Retinal fundus photograph, 848 x 848 pixels, DR severity per modified Davis staging, FOV: 45 degrees
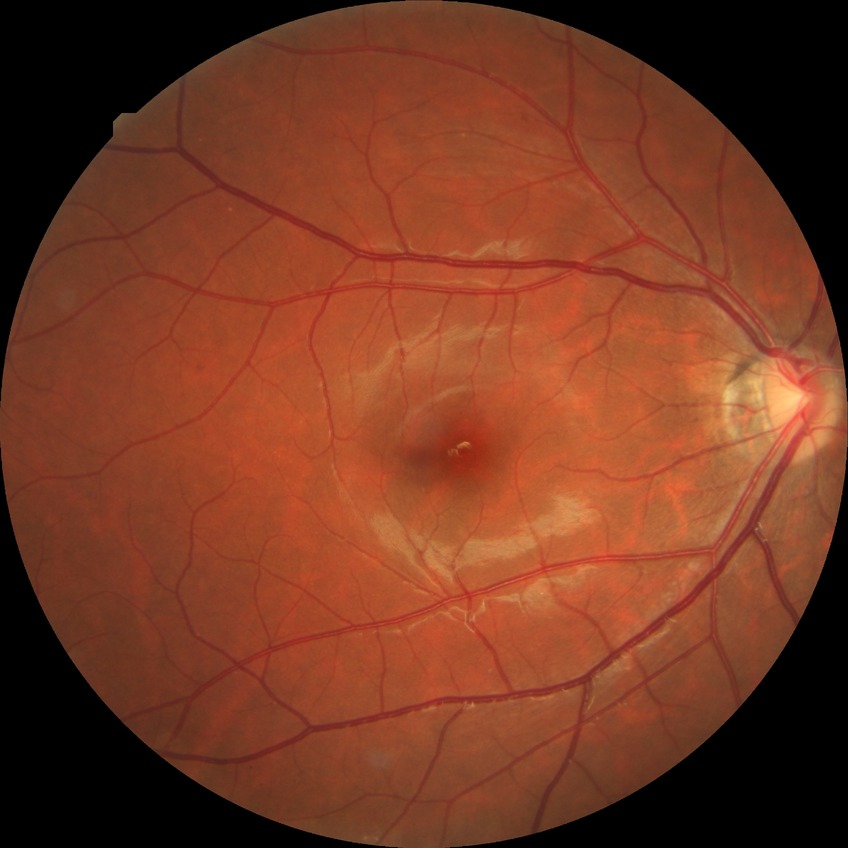
Diabetic retinopathy severity: no diabetic retinopathy.